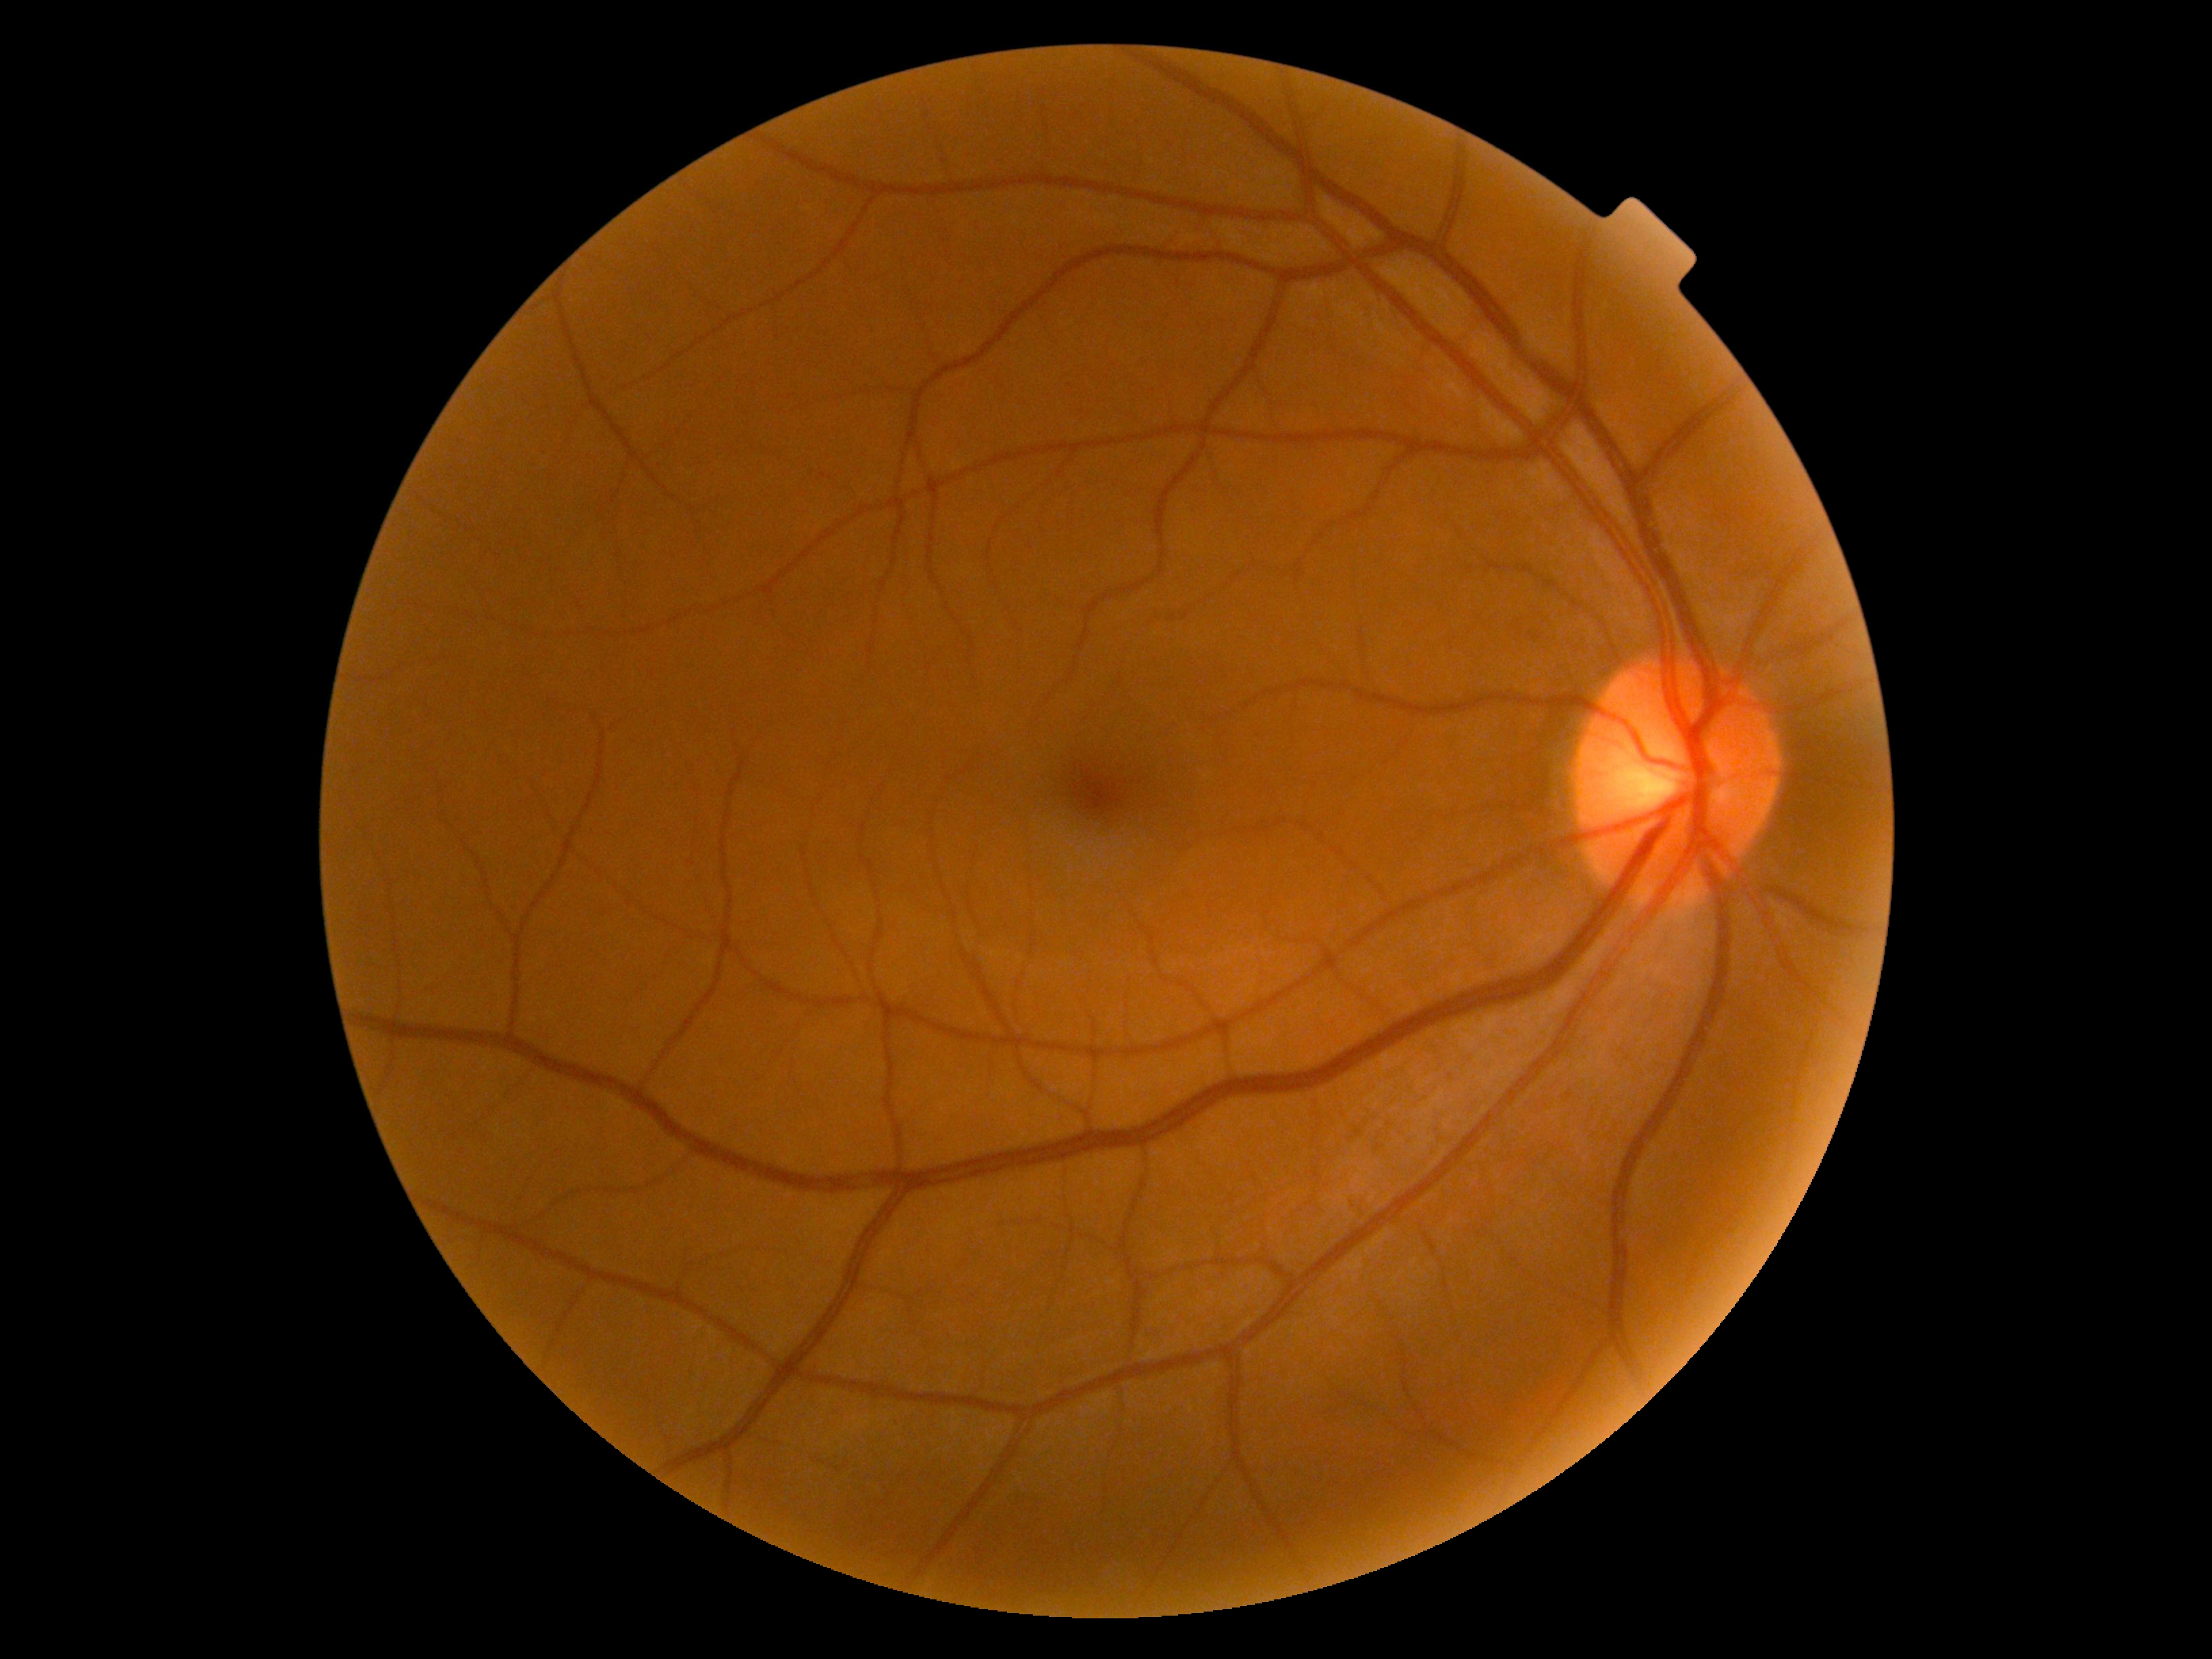
{
  "dr_grade": "grade 0"
}